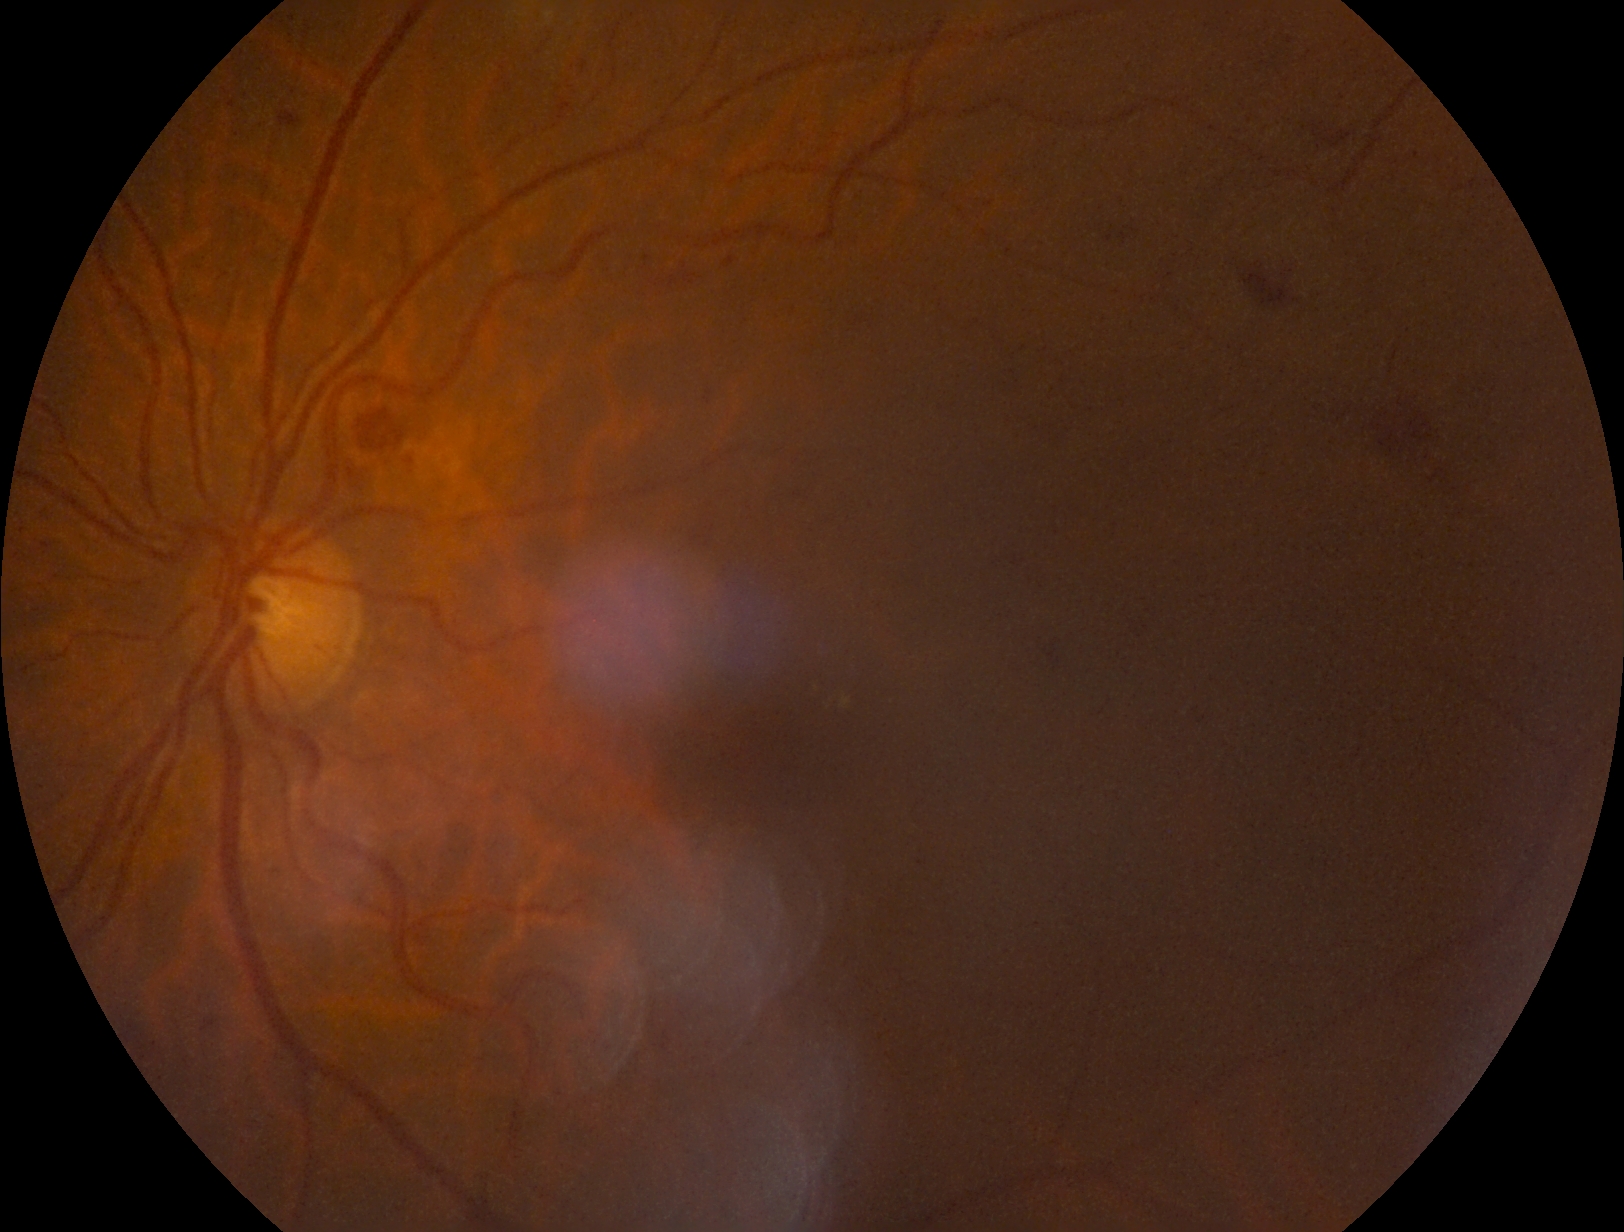

Retinopathy: 2.